Acquired on the Phoenix ICON. Wide-field fundus photograph of an infant — 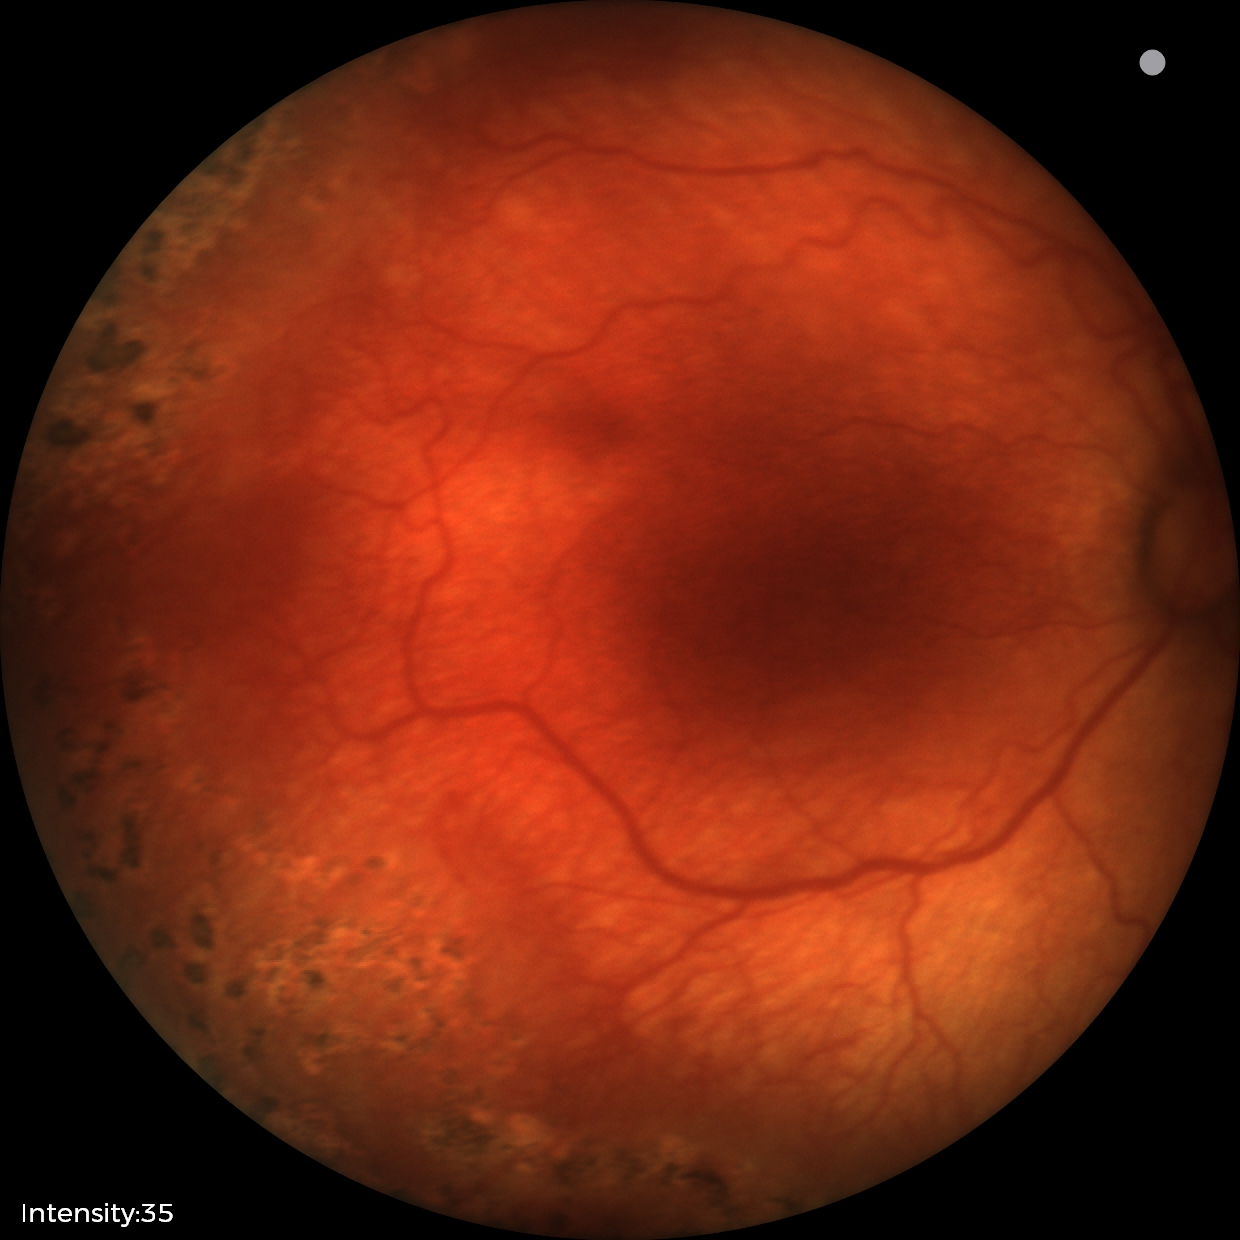
Screening diagnosis: plus disease | ROP stage 1.